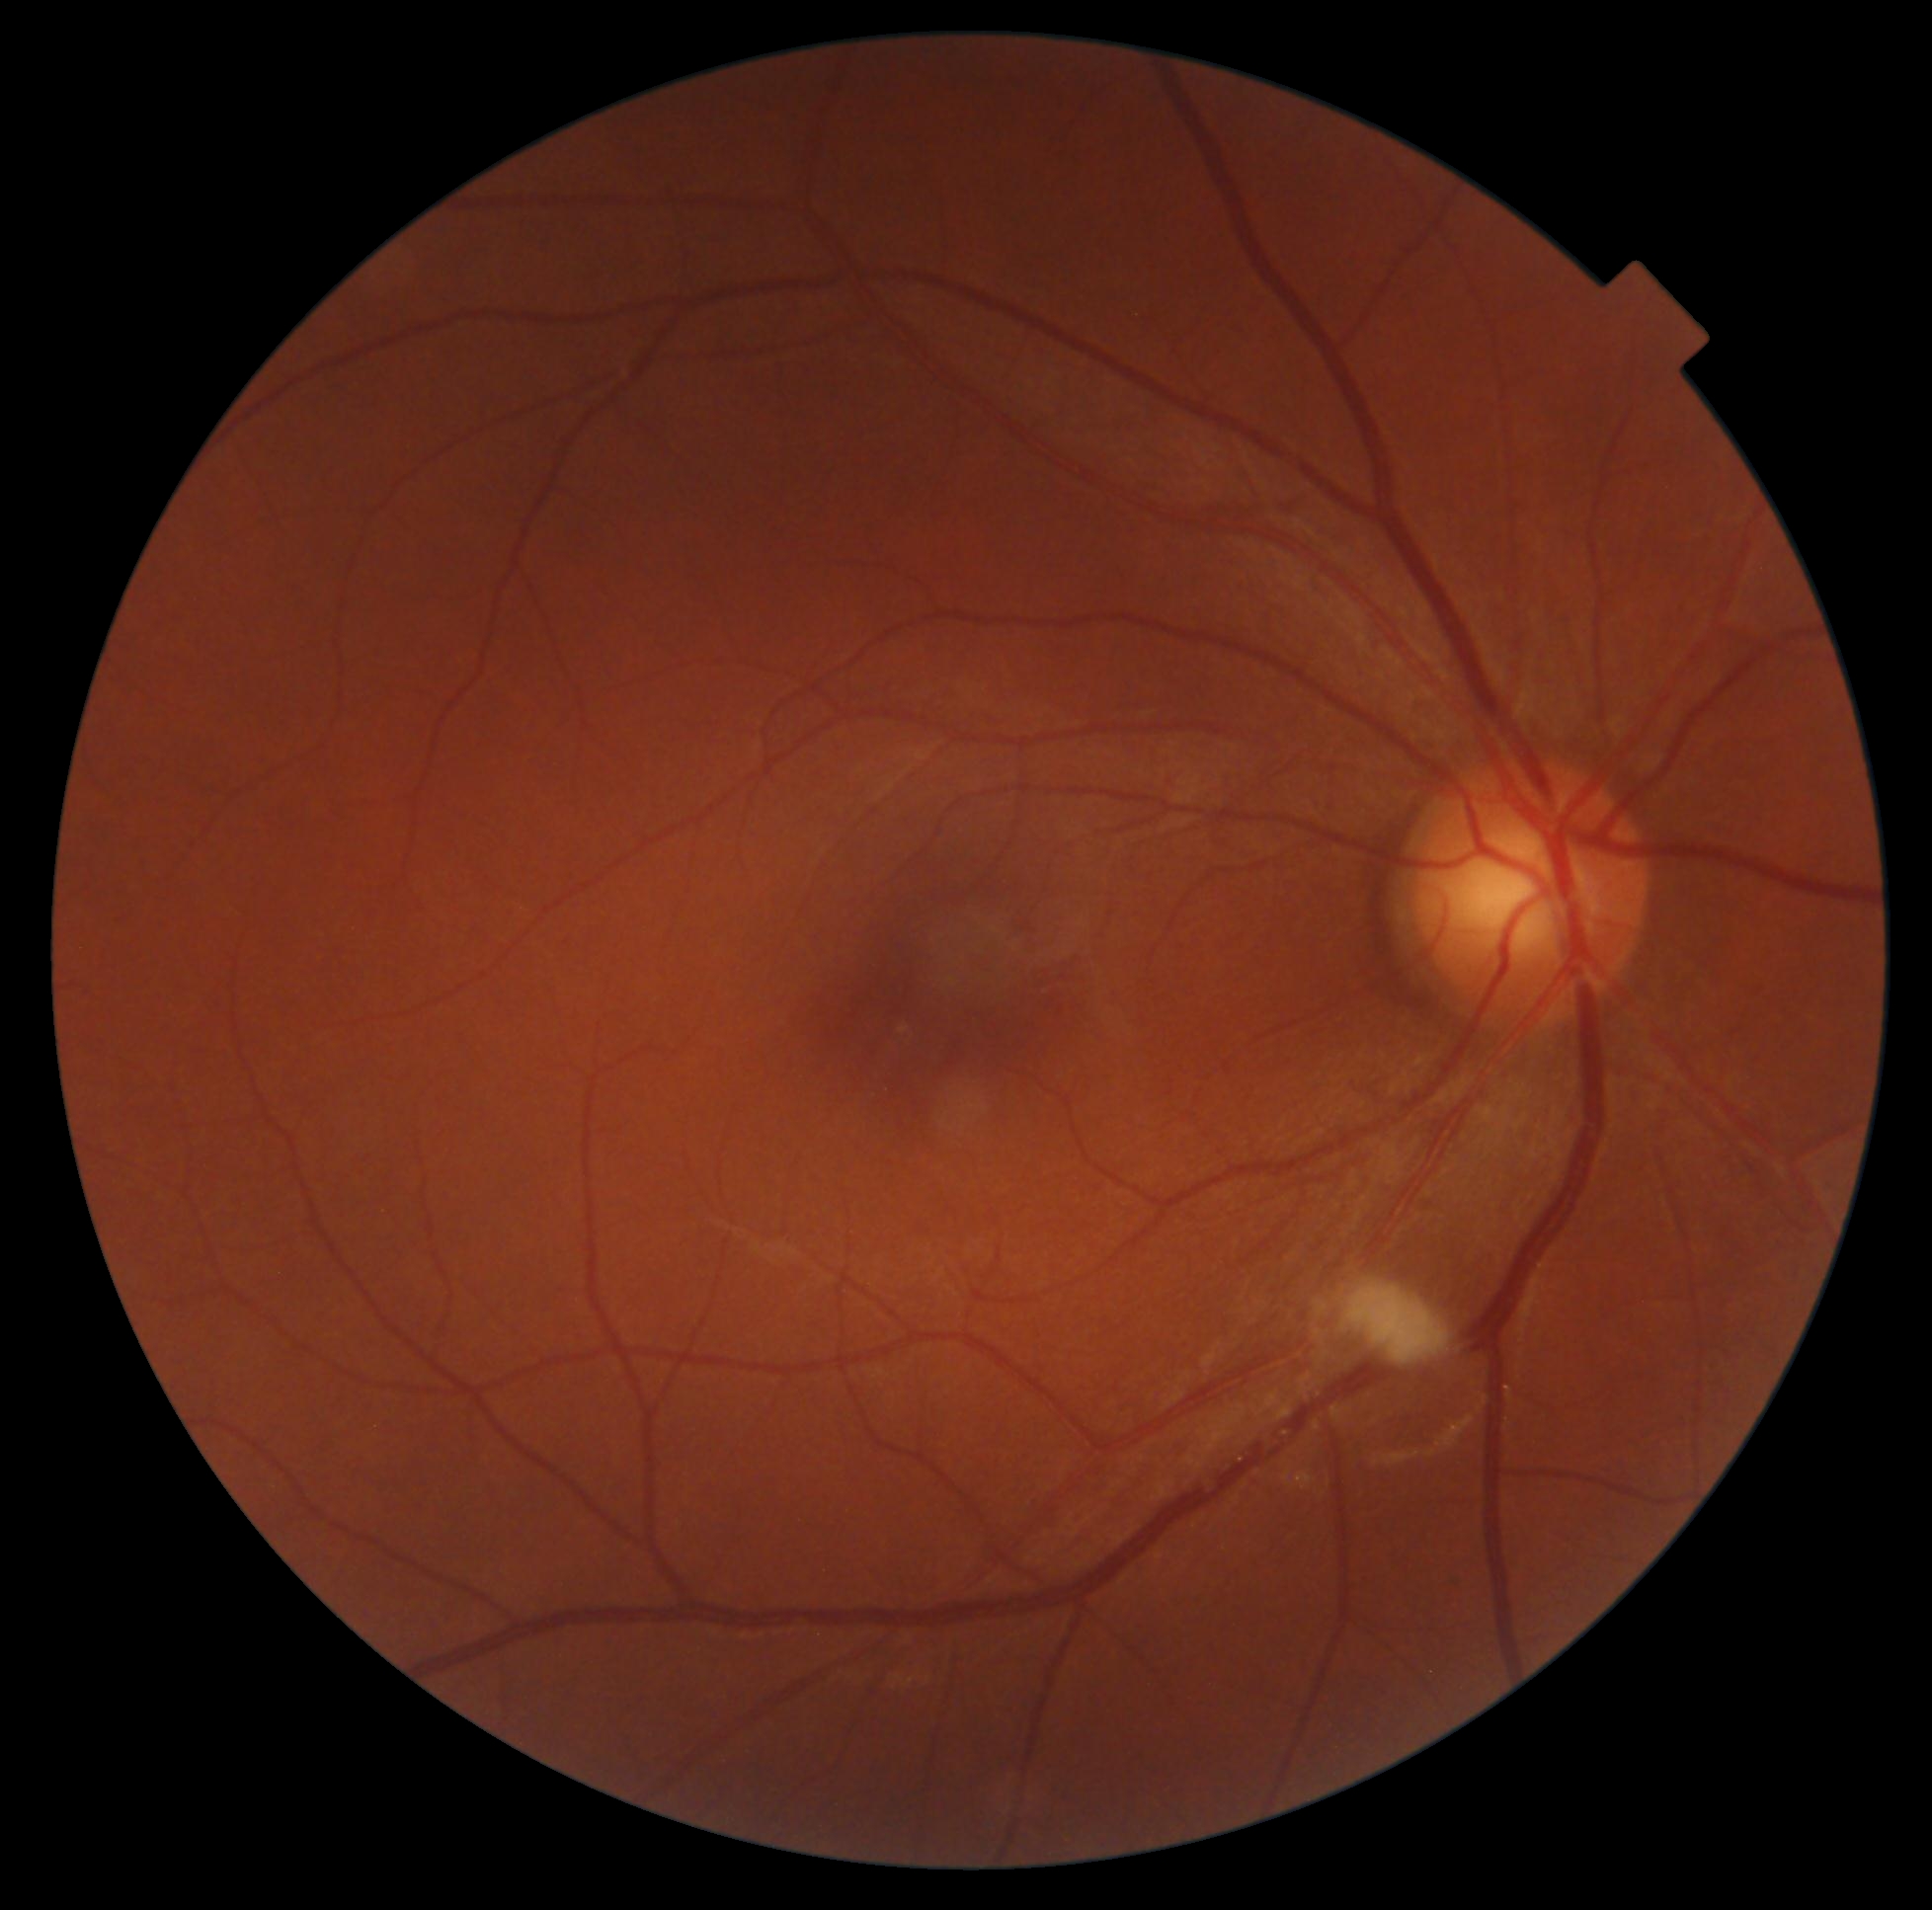

DR severity = moderate non-proliferative diabetic retinopathy (grade 2).